2352x1568px.
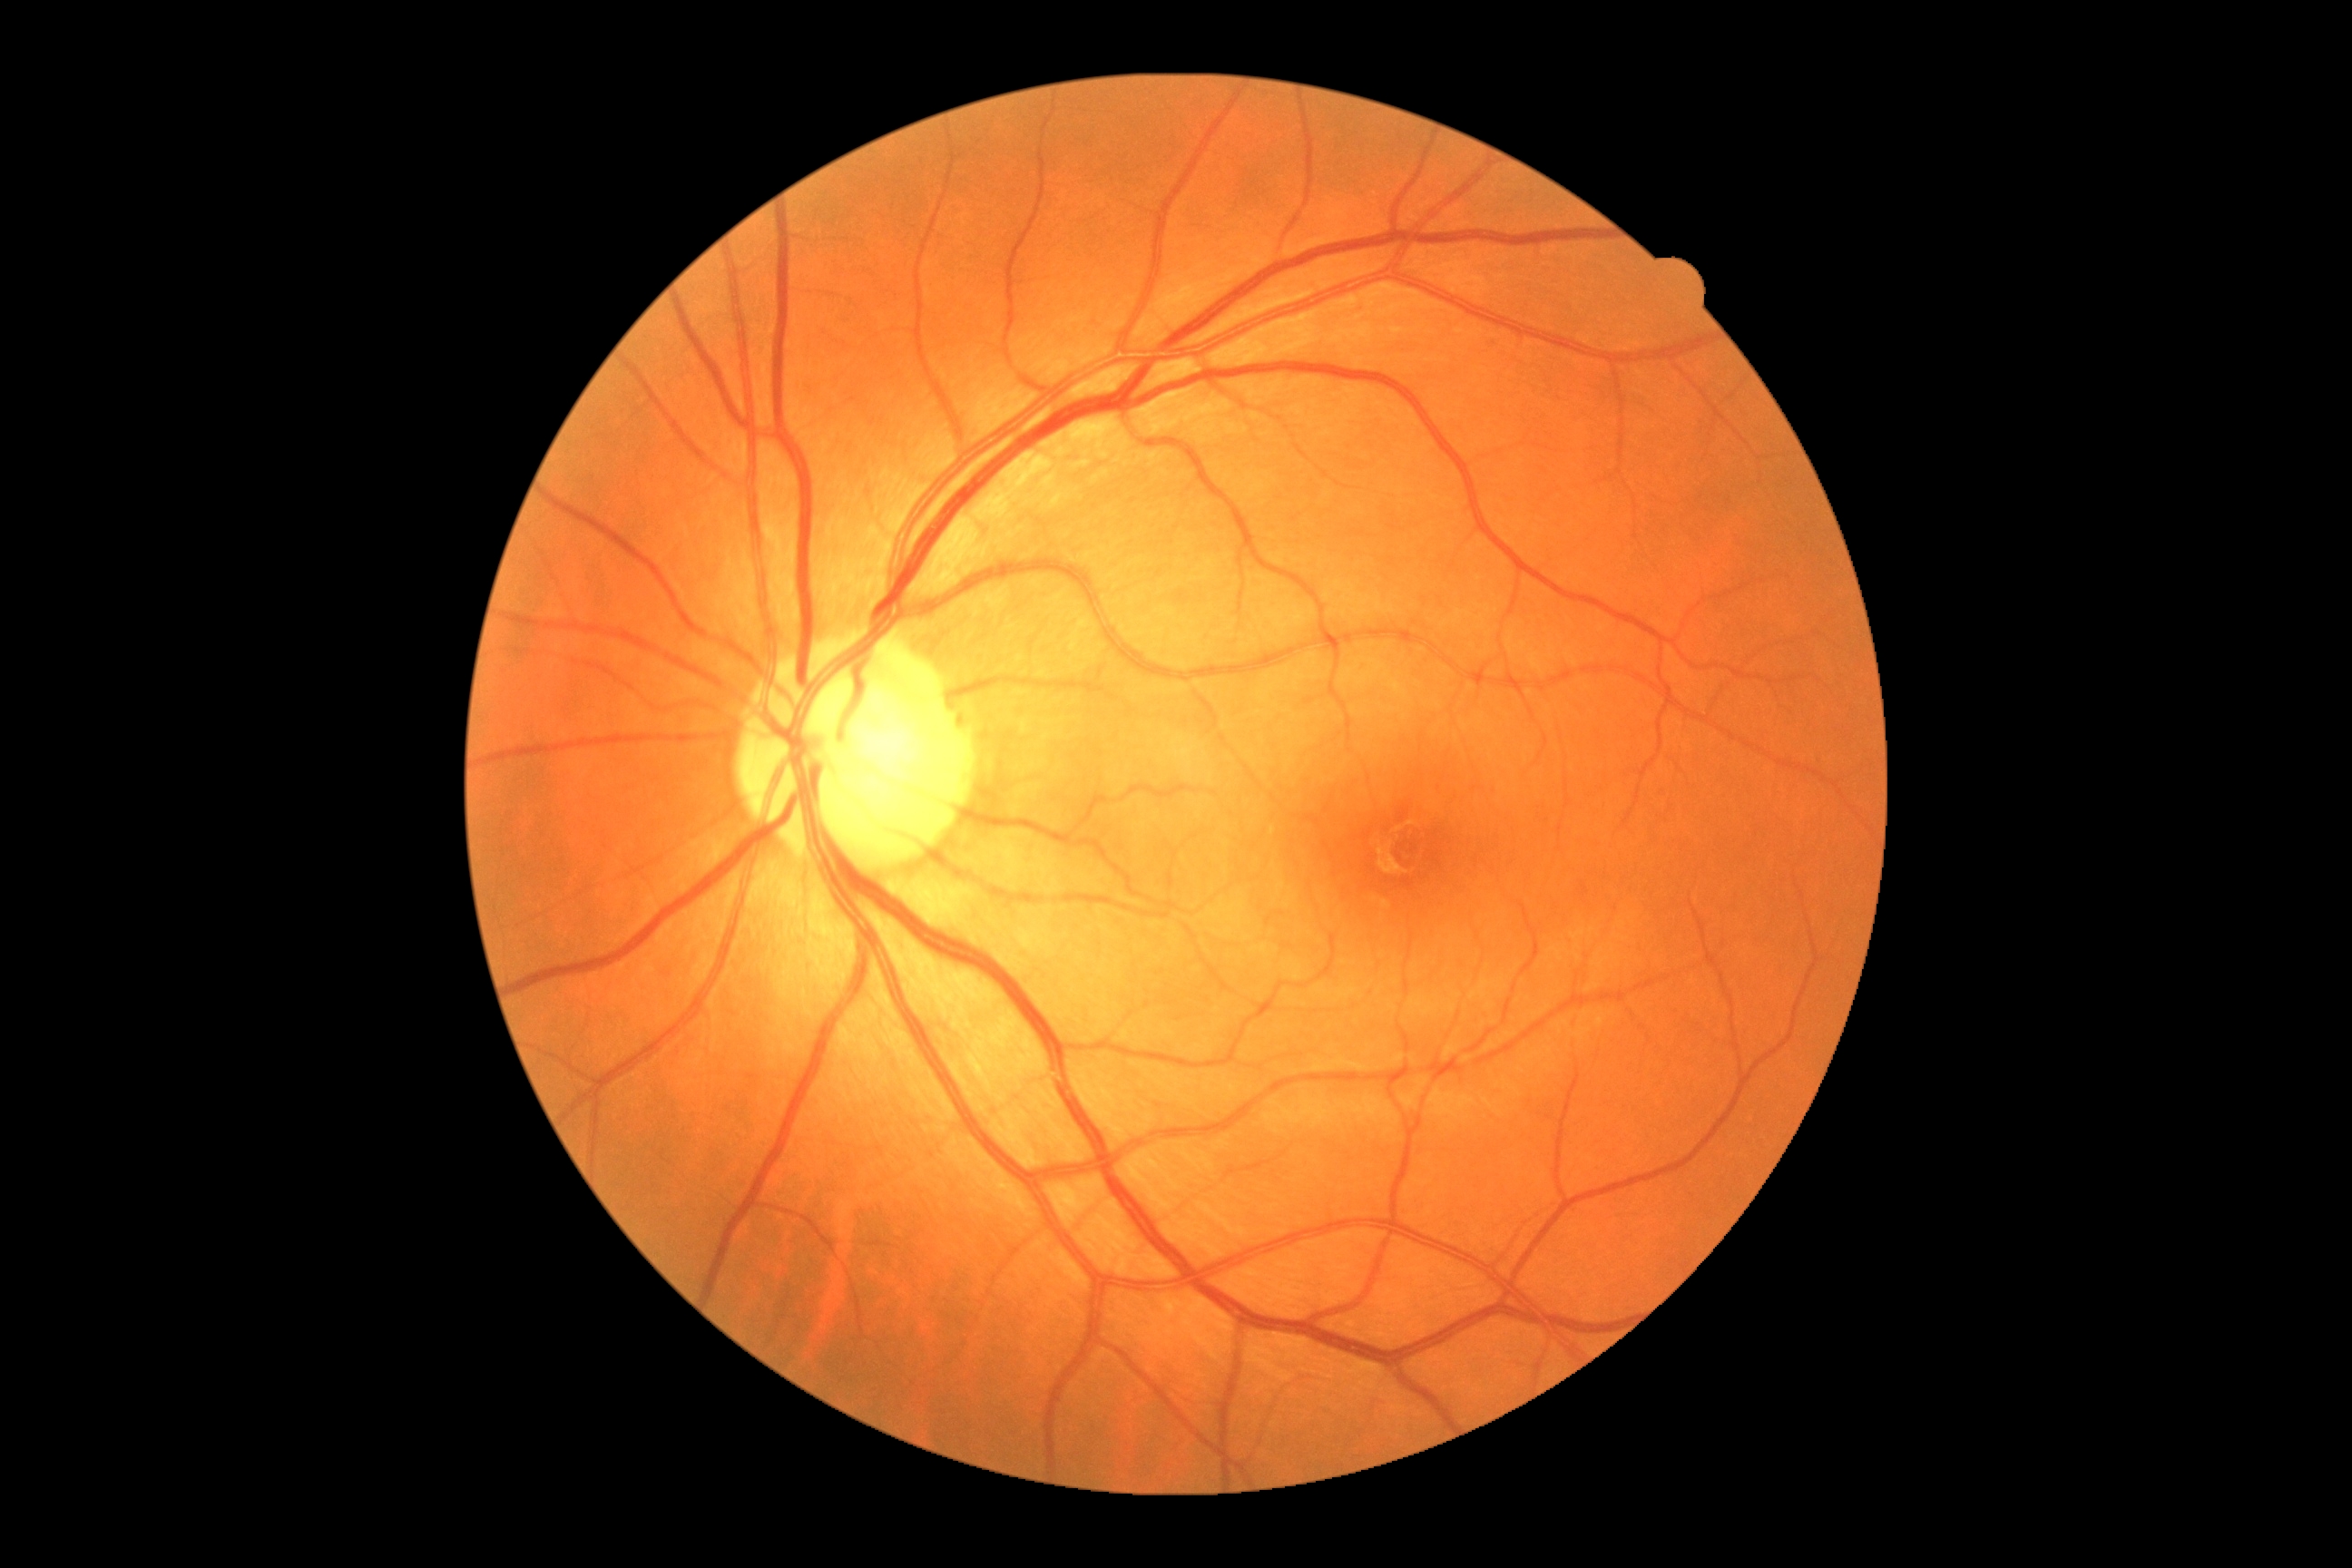
DR grade: no apparent diabetic retinopathy (0), DR impression: no signs of DR.